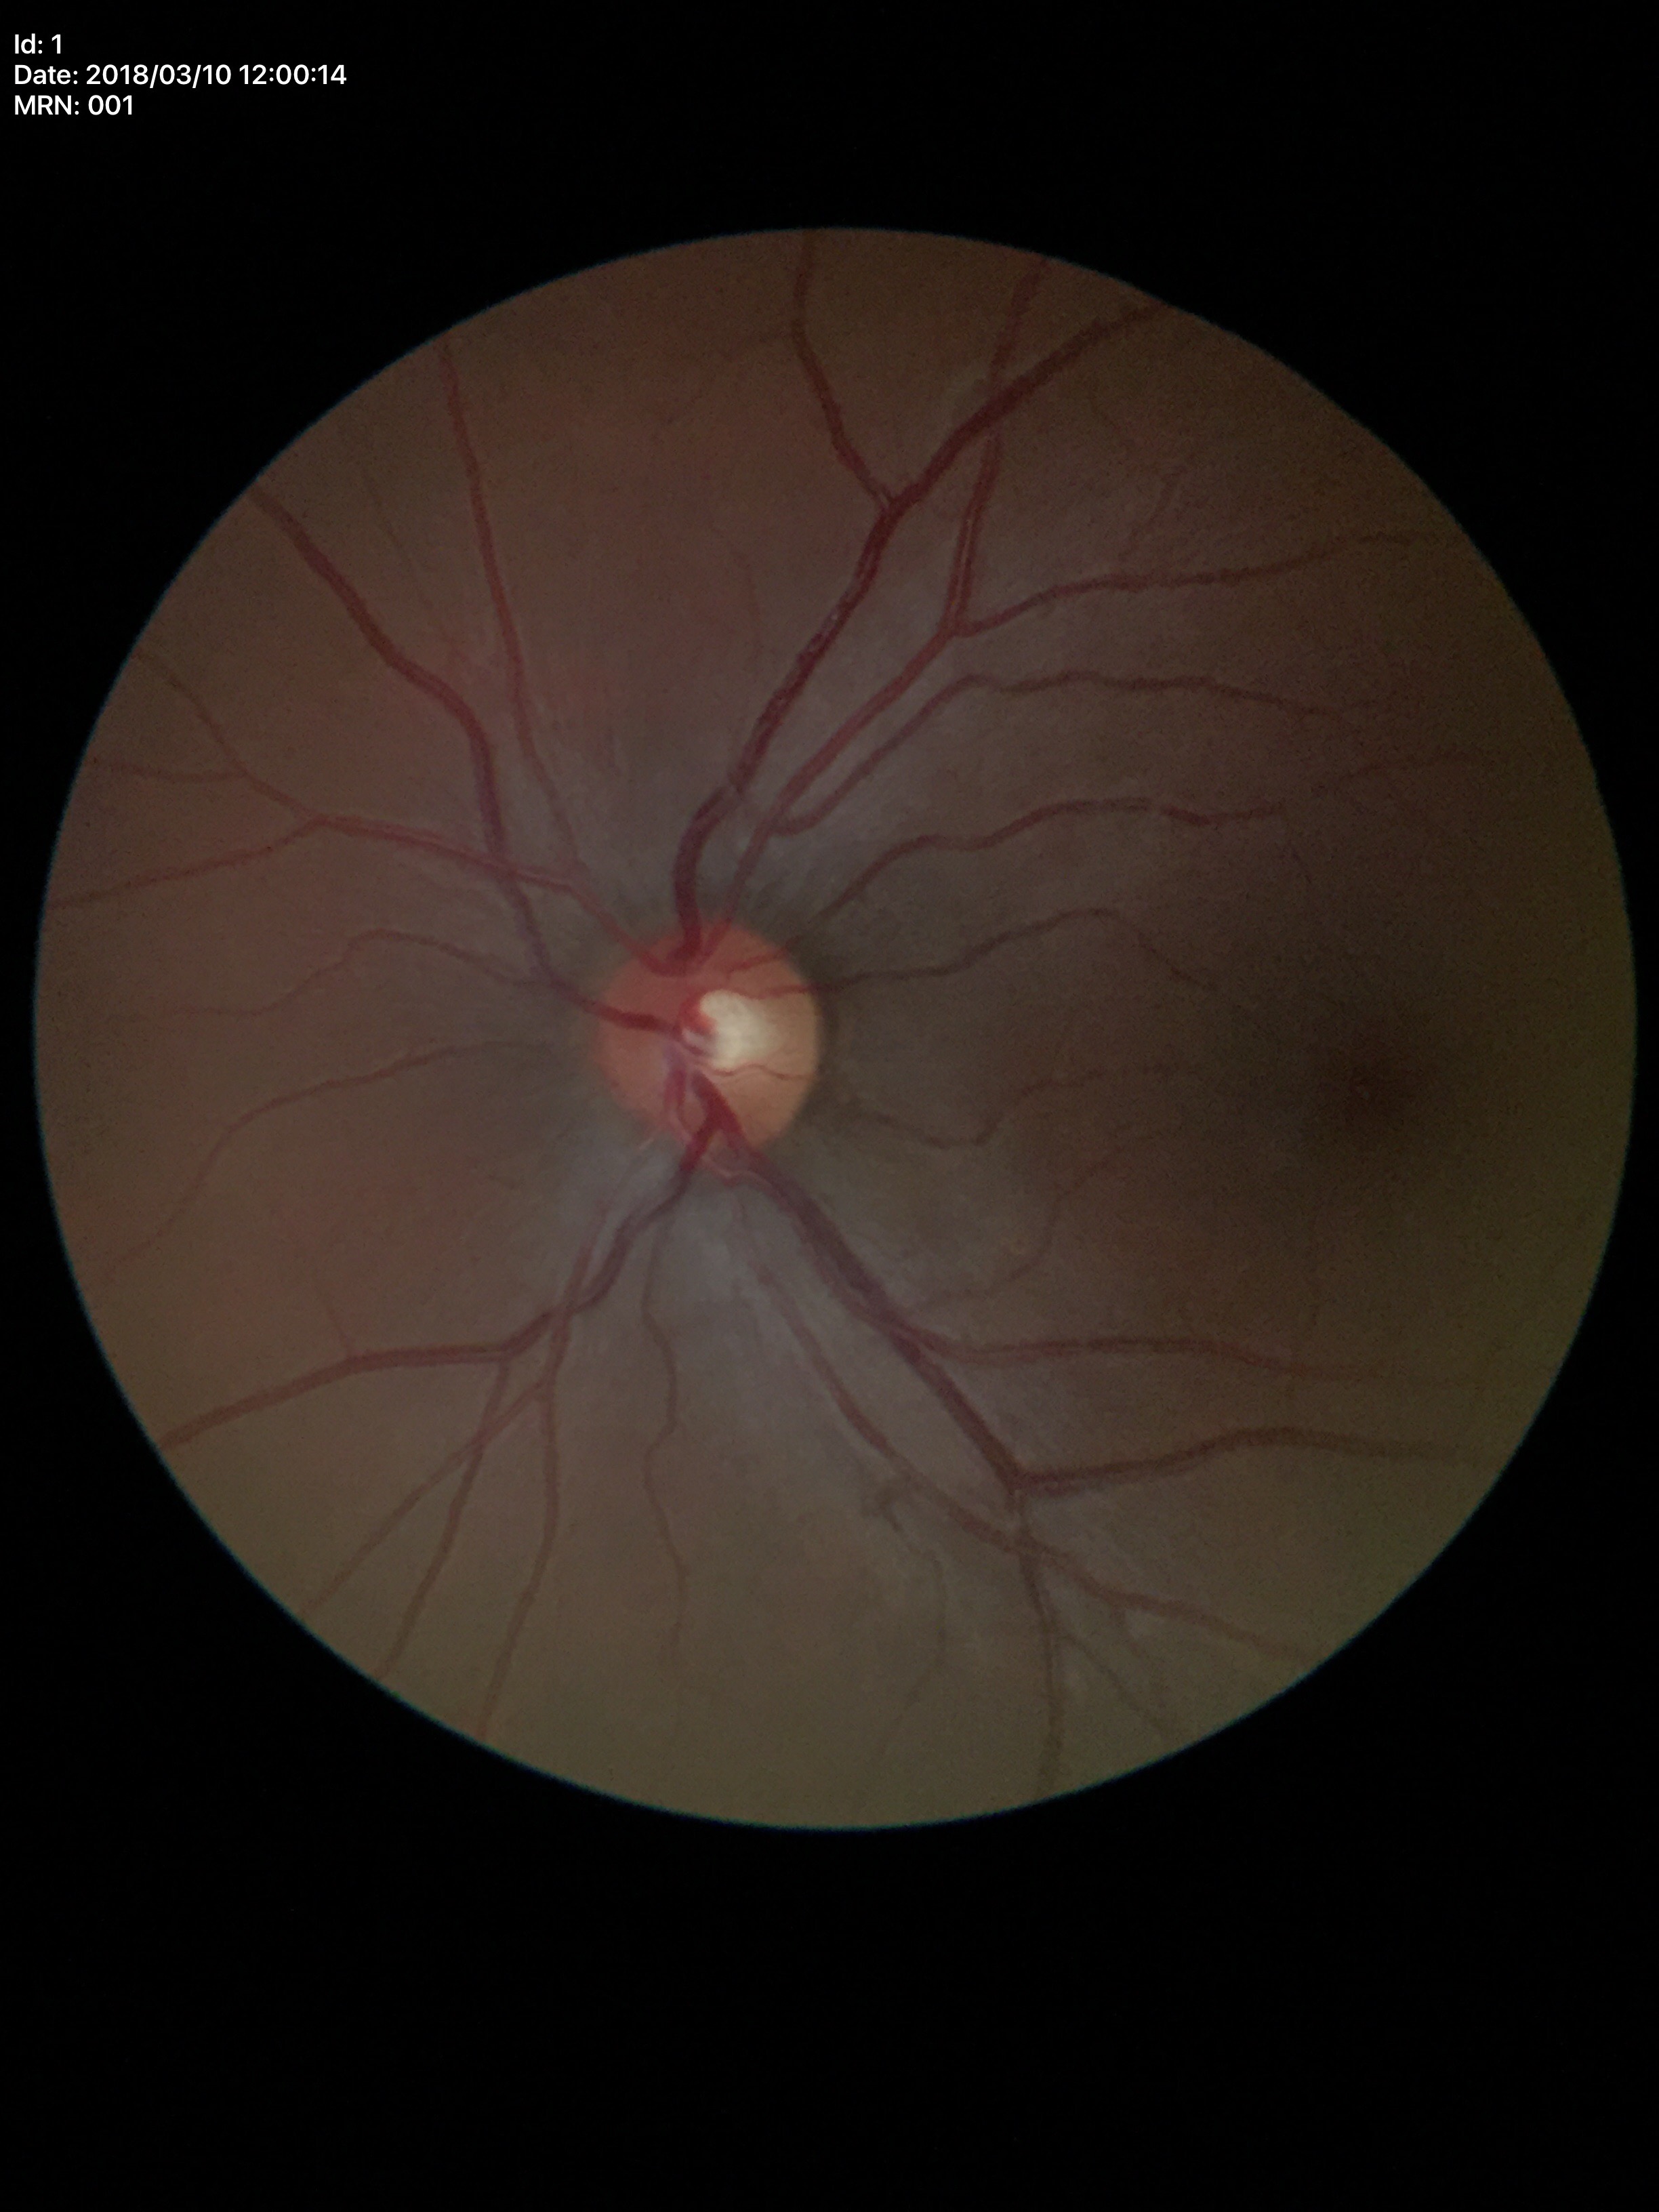 vertical cup-to-disc ratio (VCDR): 0.42, Glaucoma screening impression: no suspicious findings (all 5 graders called normal).